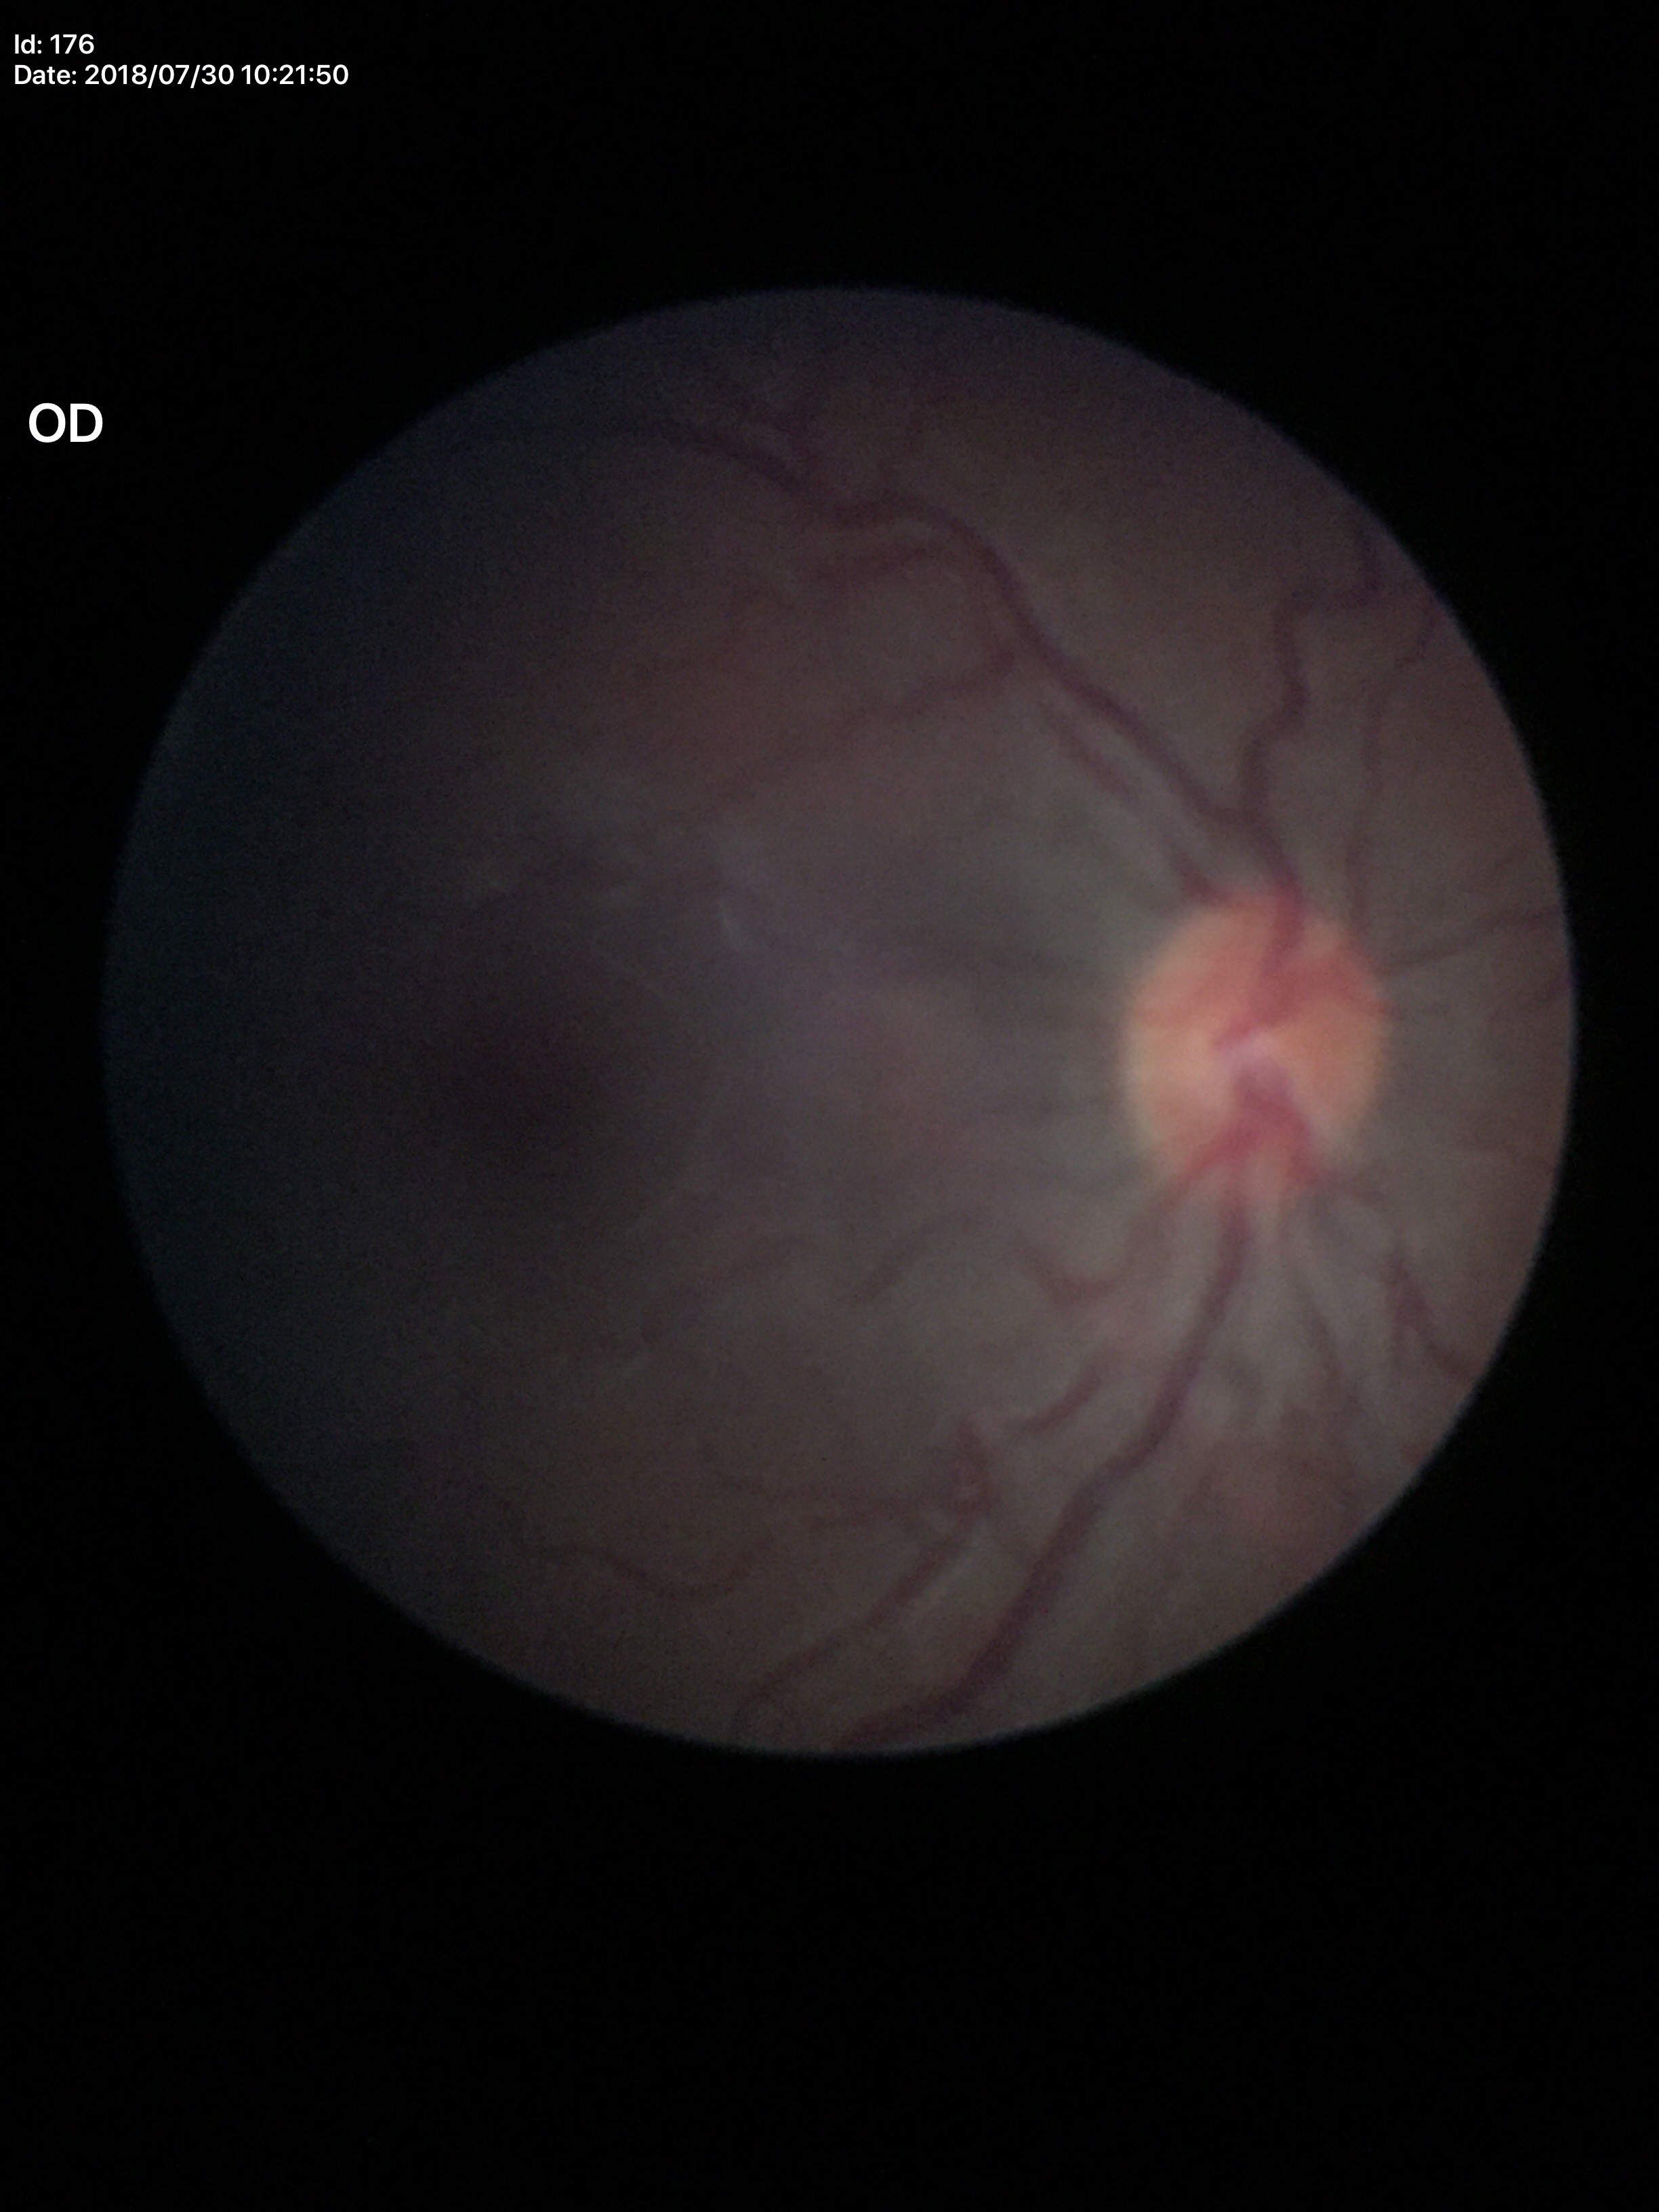 Annotations:
- vertical CDR — 0.47
- horizontal cup-disc ratio — 0.49
- Glaucoma impression — not suspect